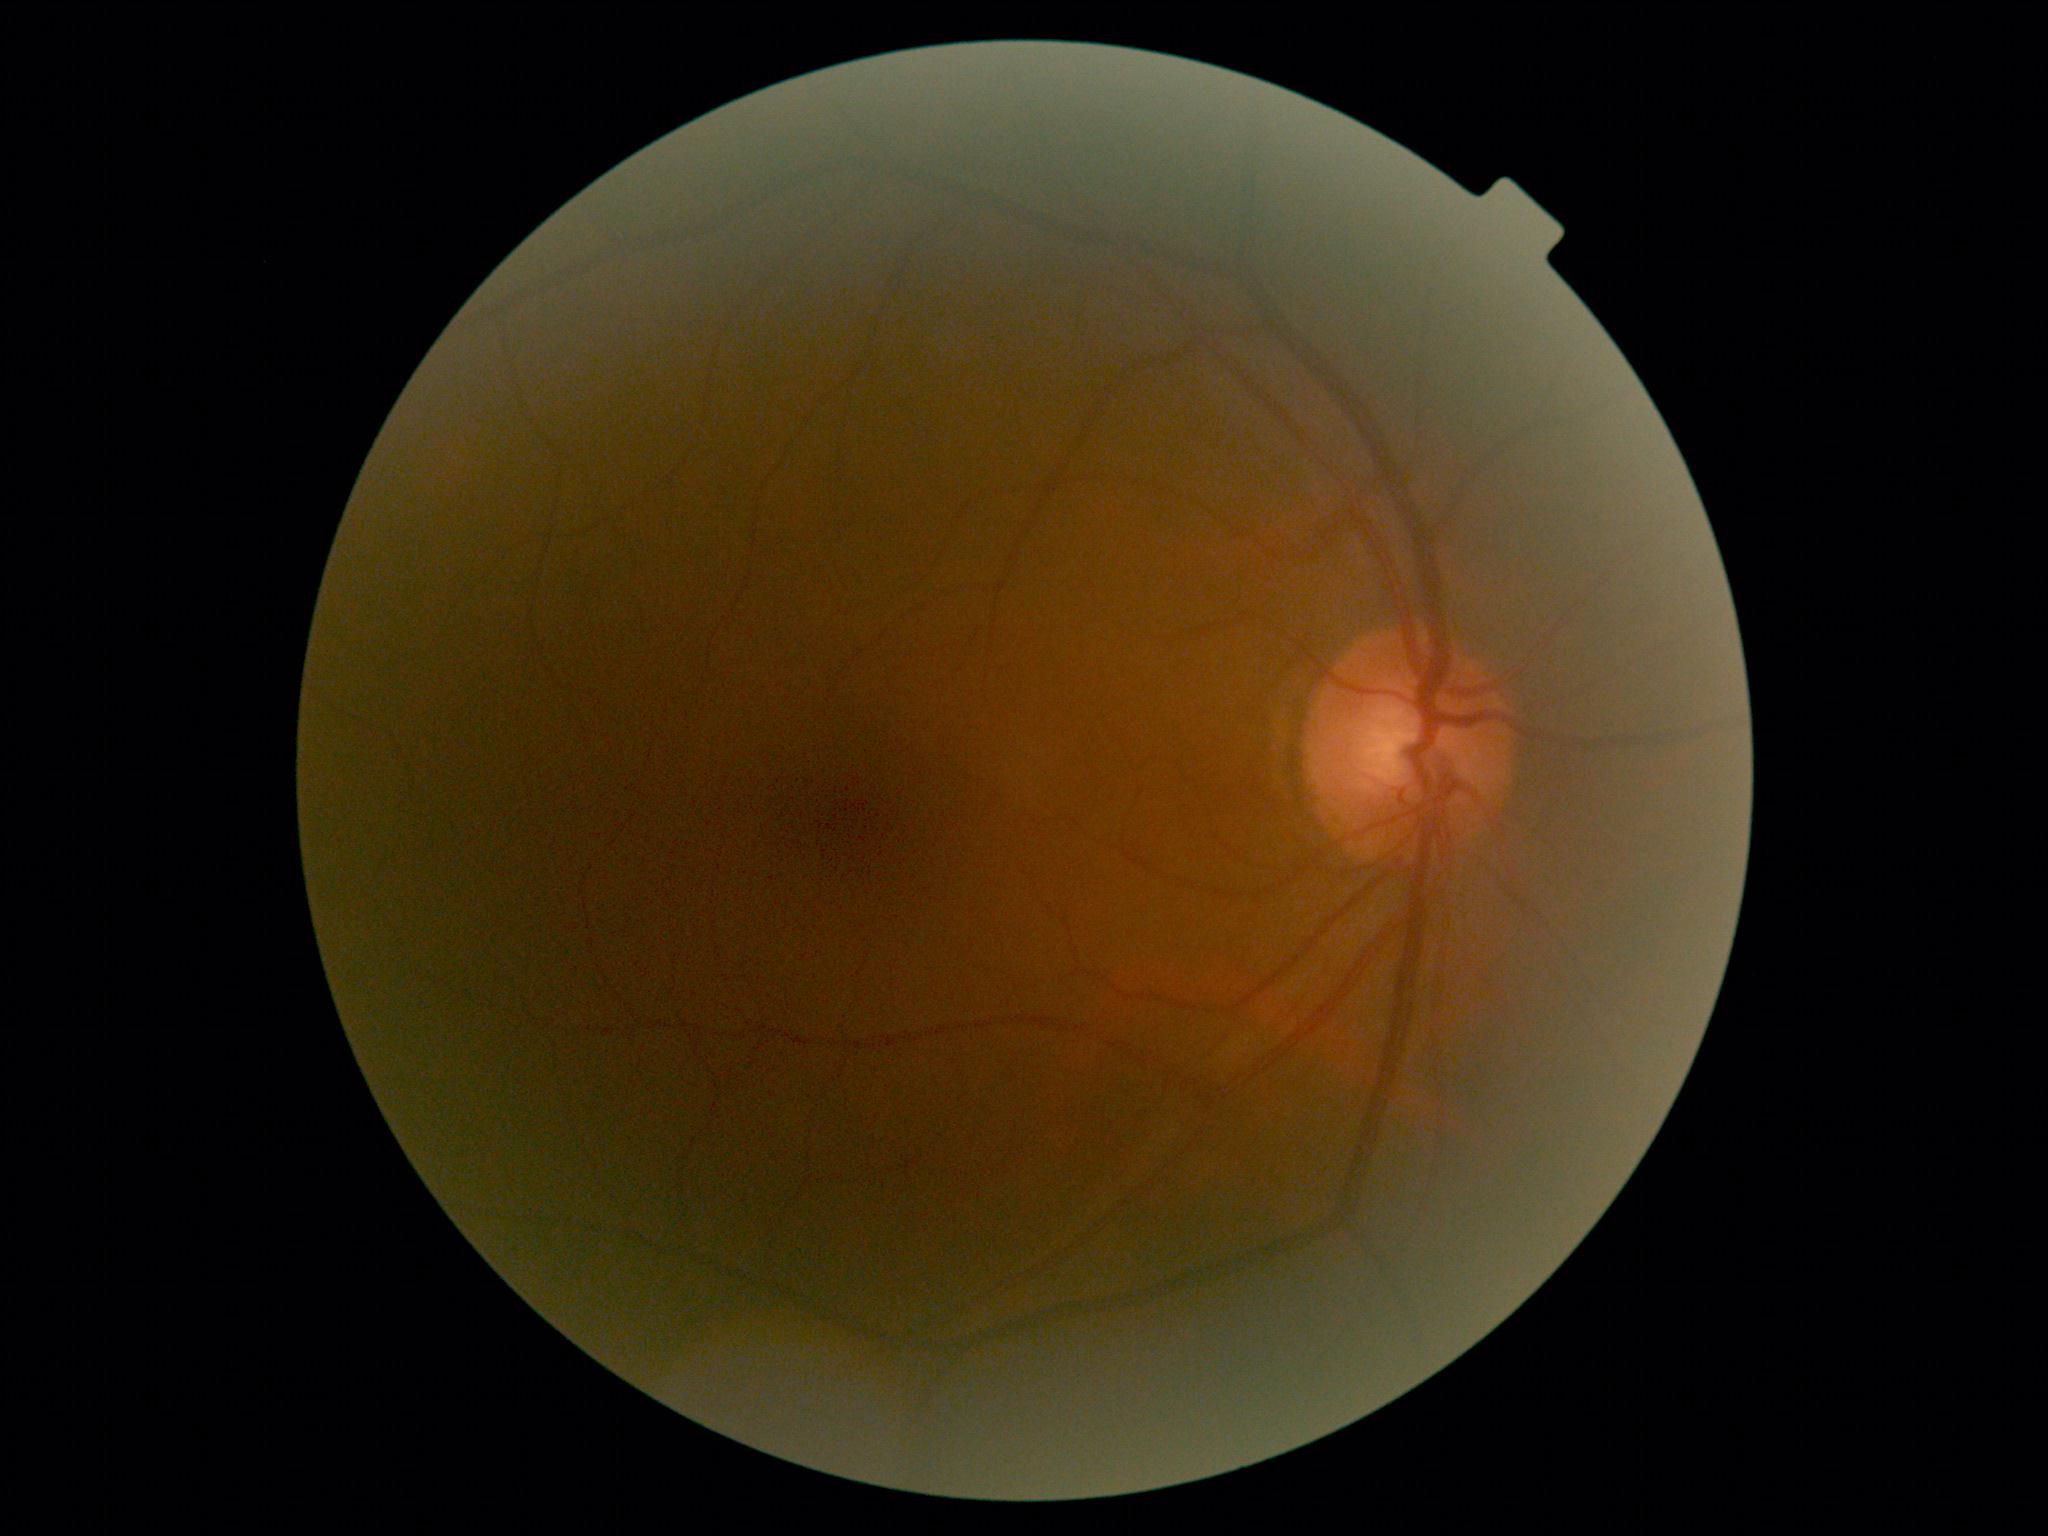

Findings:
– DR impression: negative for DR
– DR: grade 0 — no visible signs of diabetic retinopathy